Color fundus photograph. FOV: 45 degrees. 848x848px. Without pupil dilation. NIDEK AFC-230 fundus camera
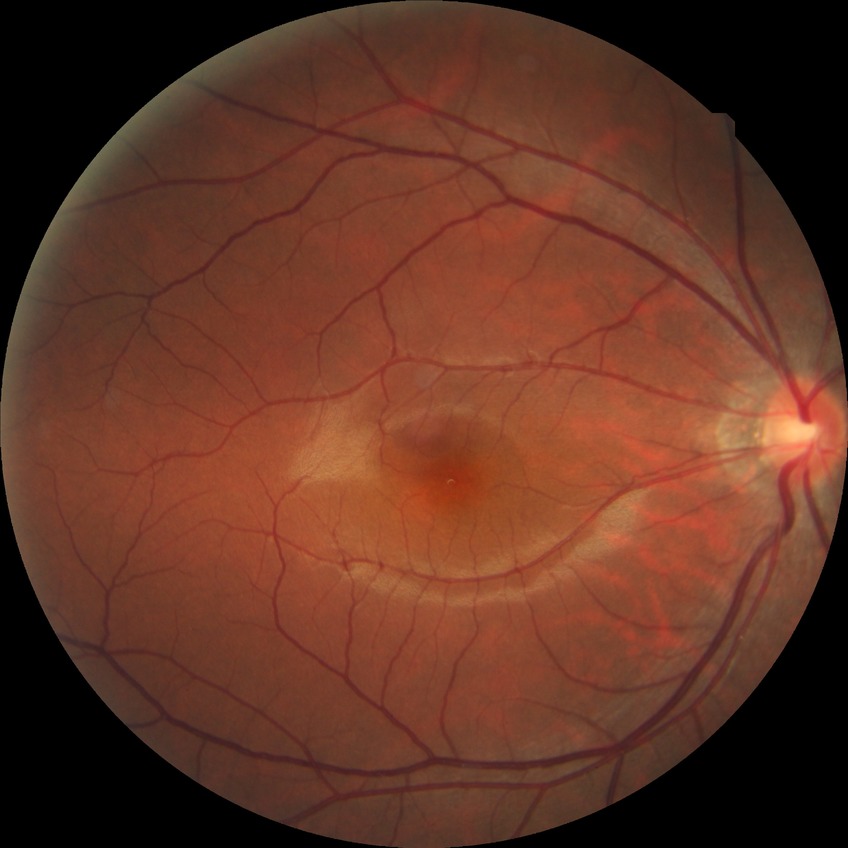
Diabetic retinopathy grade is no diabetic retinopathy.